Wide-field contact fundus photograph of an infant. 1240 x 1240 pixels:
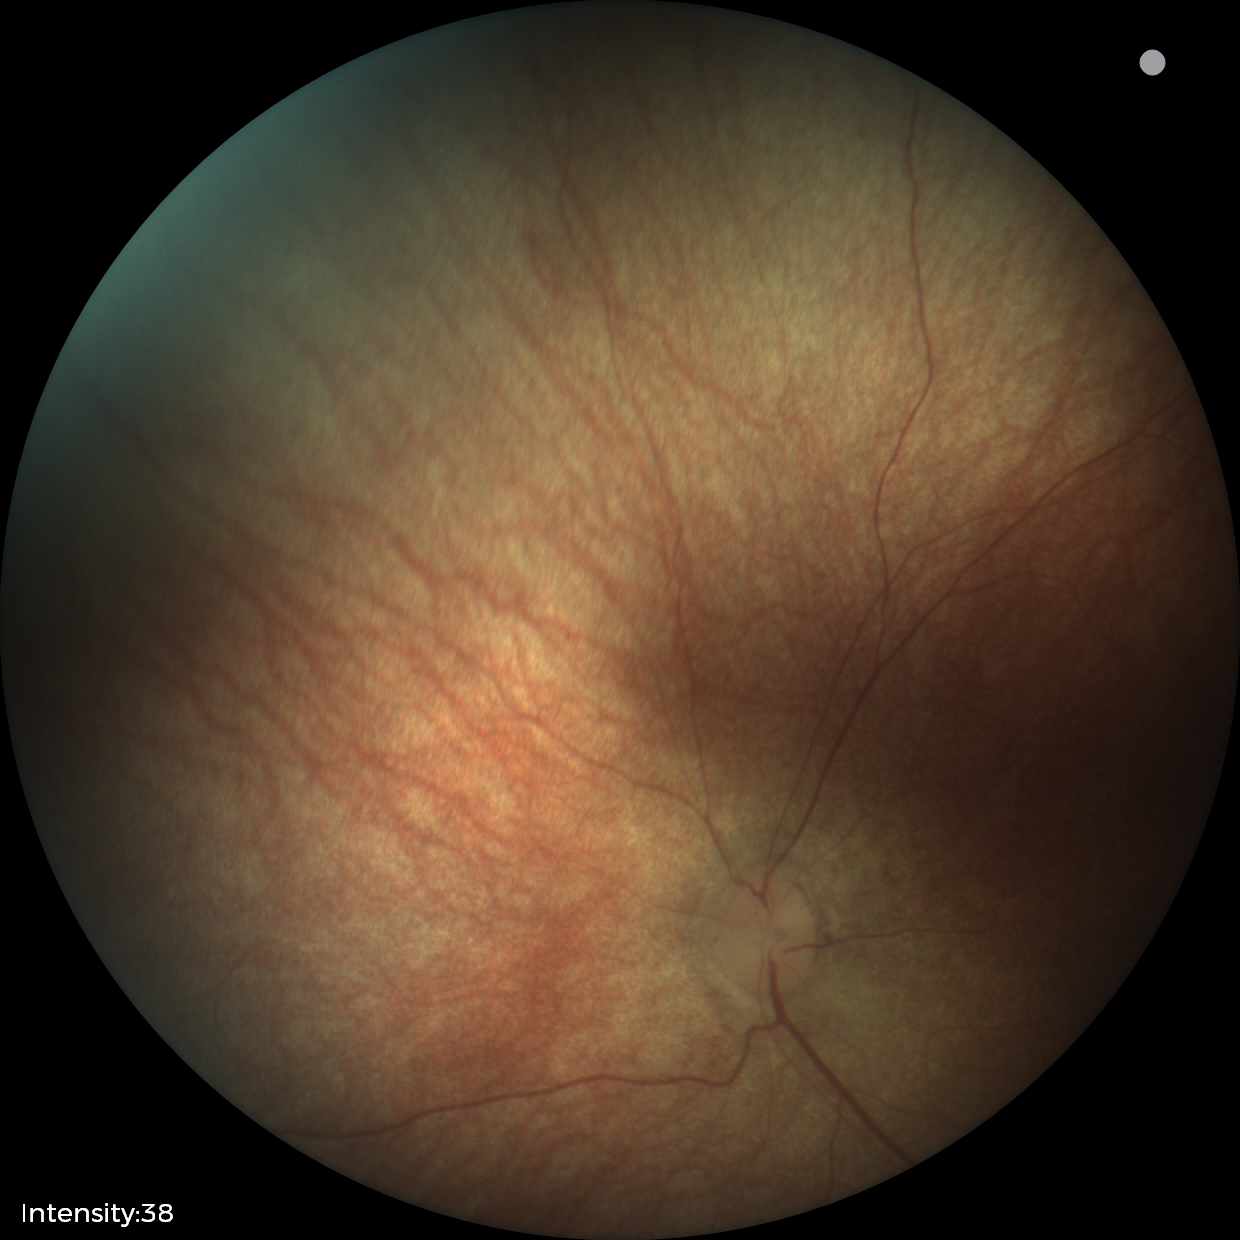
Normal screening examination.